Fundus photo. Modified Davis classification. NIDEK AFC-230 fundus camera — 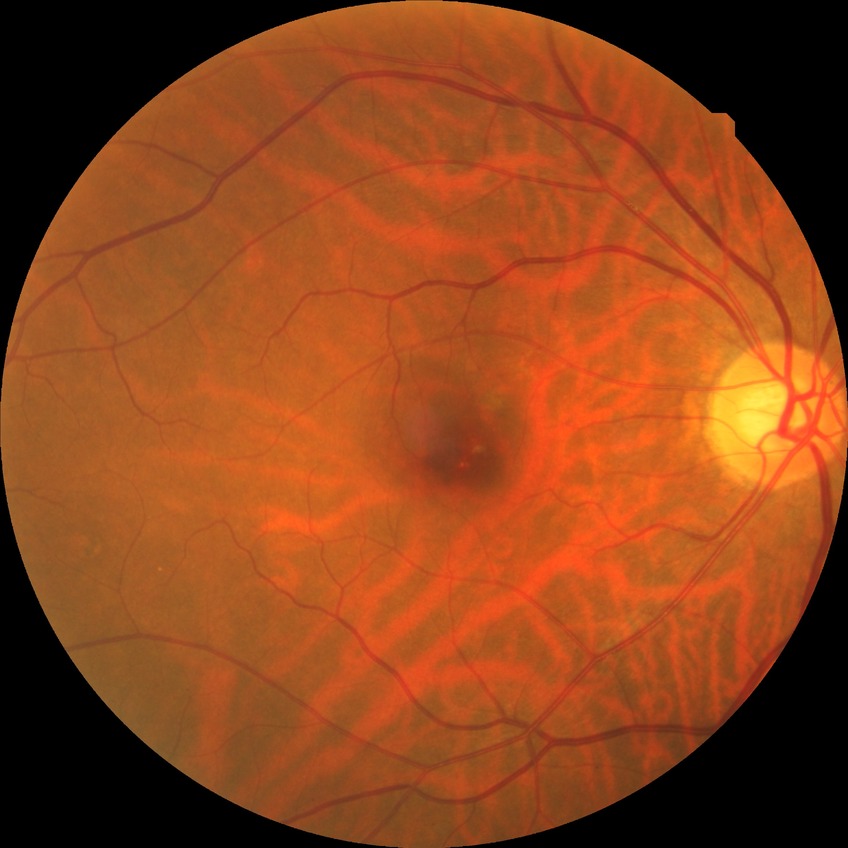 Diabetic retinopathy (DR) is NDR (no diabetic retinopathy).